2352 x 1568 pixels:
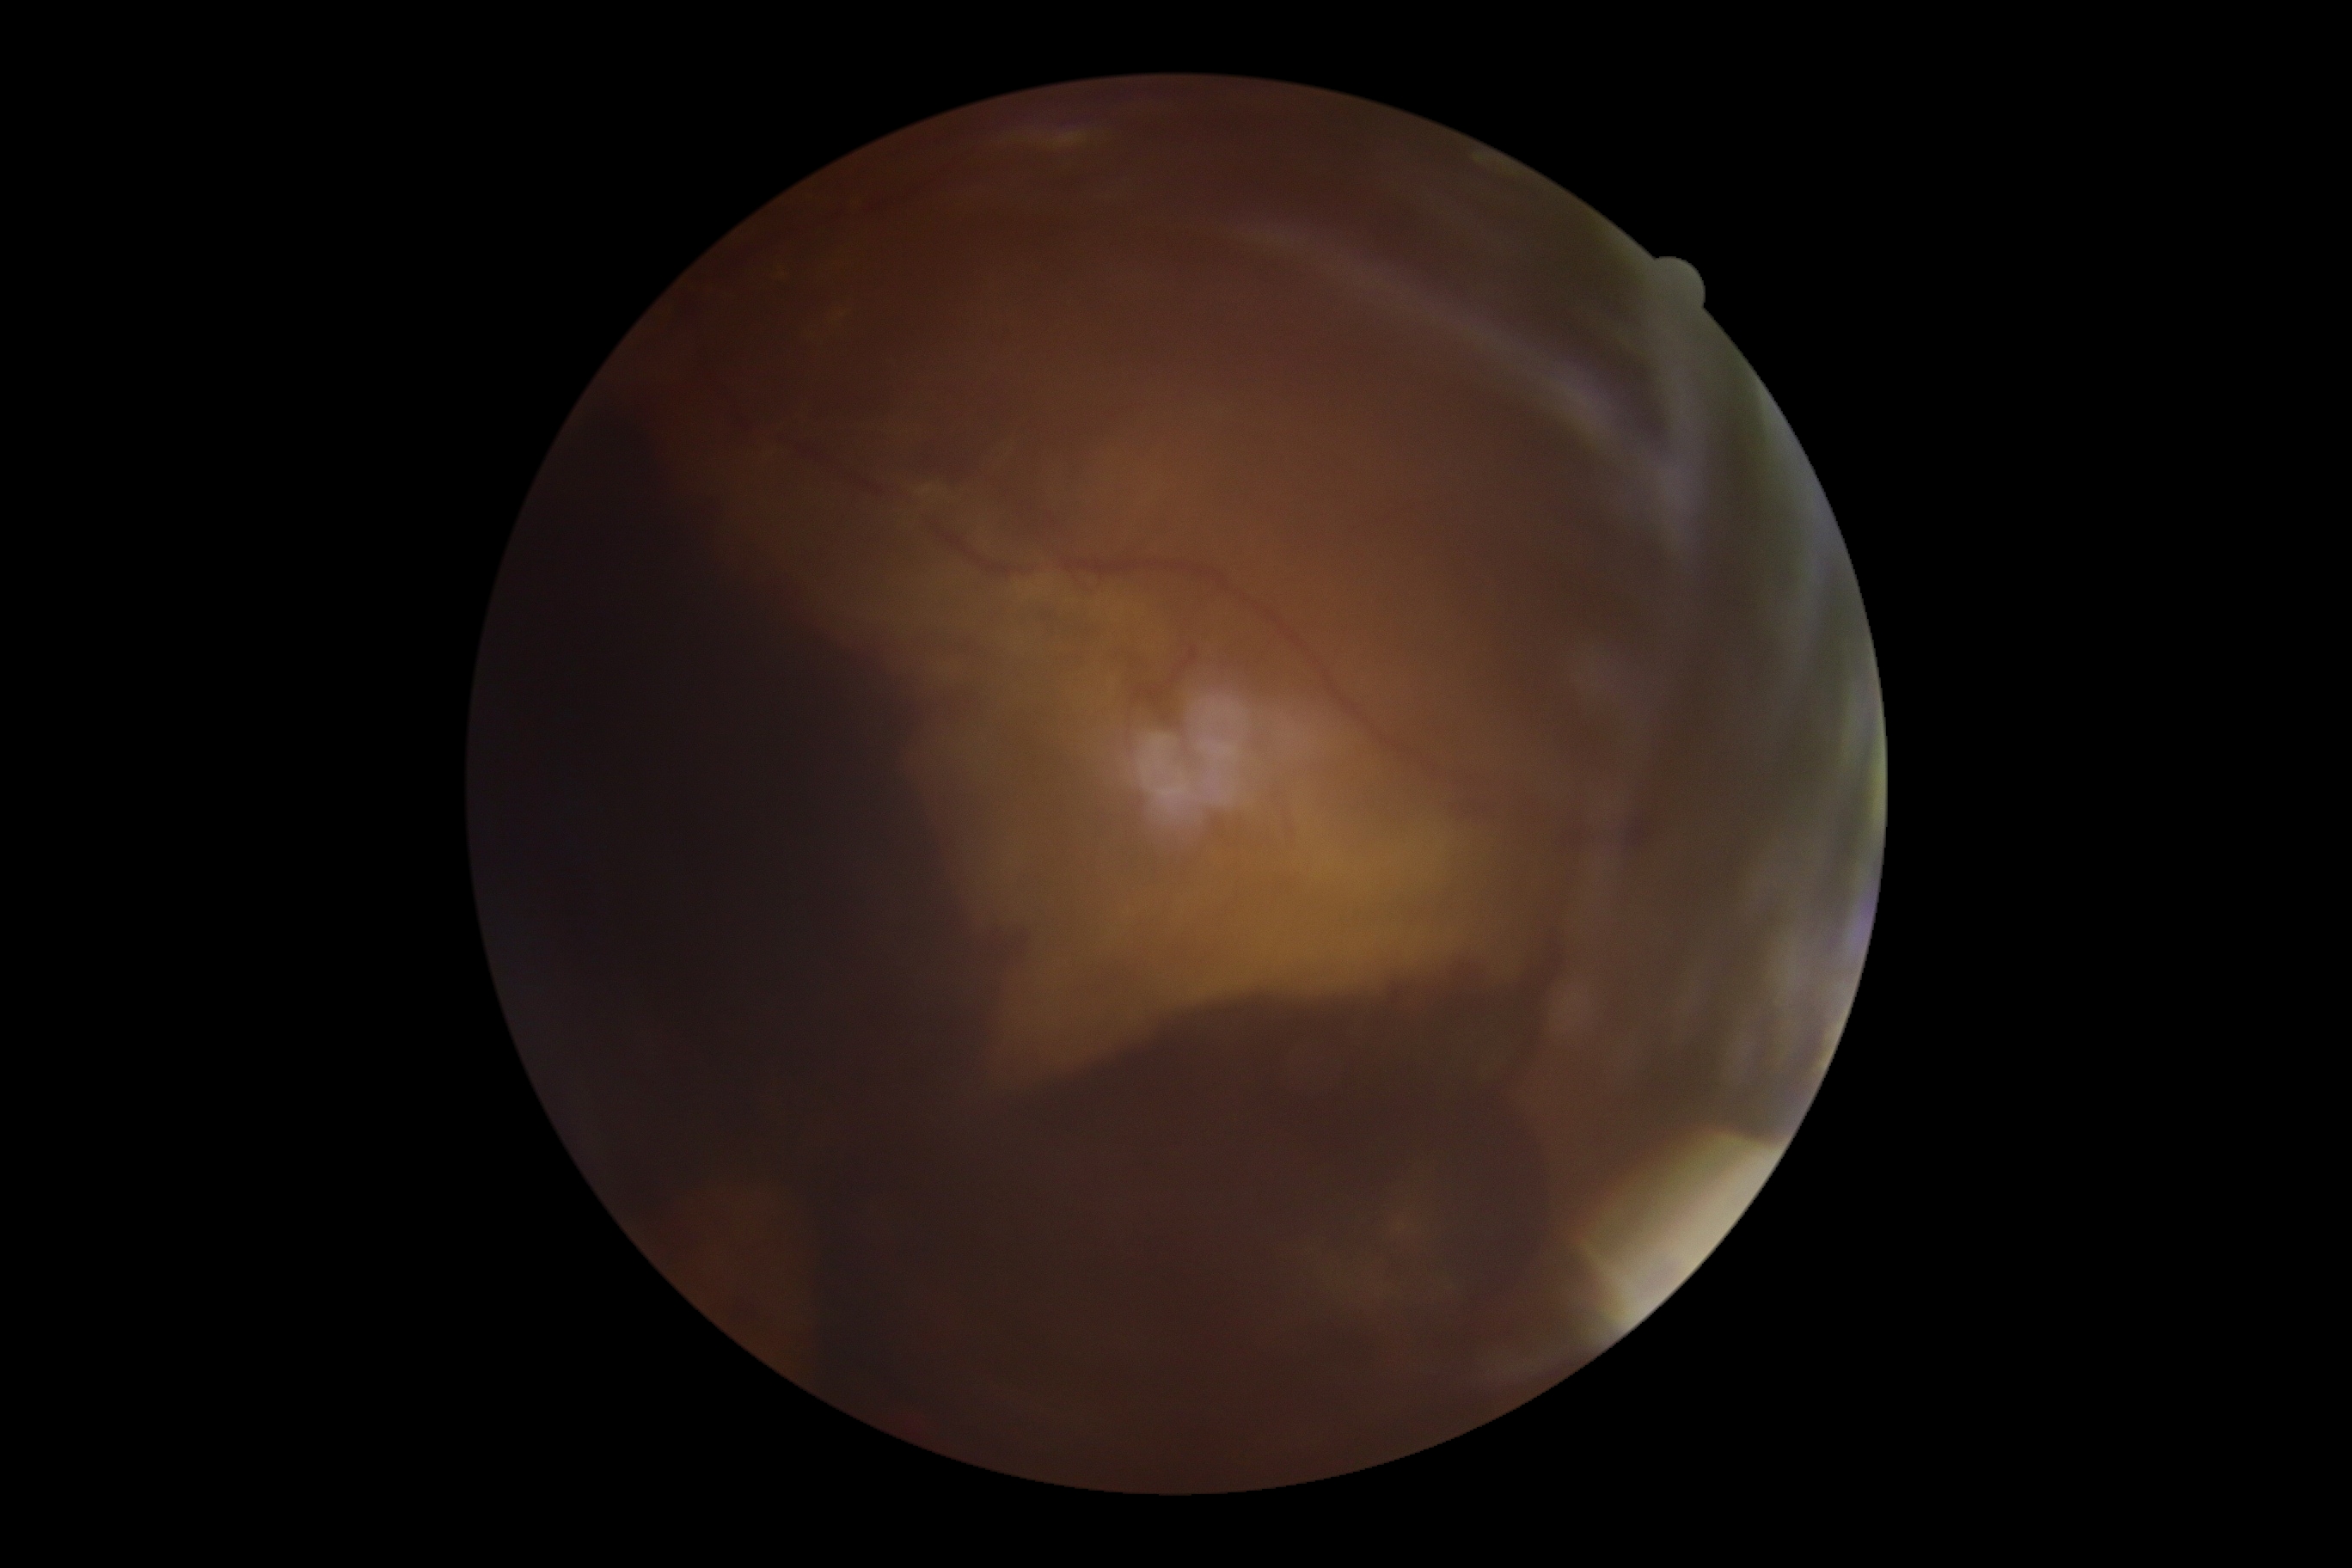
DR stage is proliferative diabetic retinopathy (grade 4). Disease class: proliferative diabetic retinopathy.